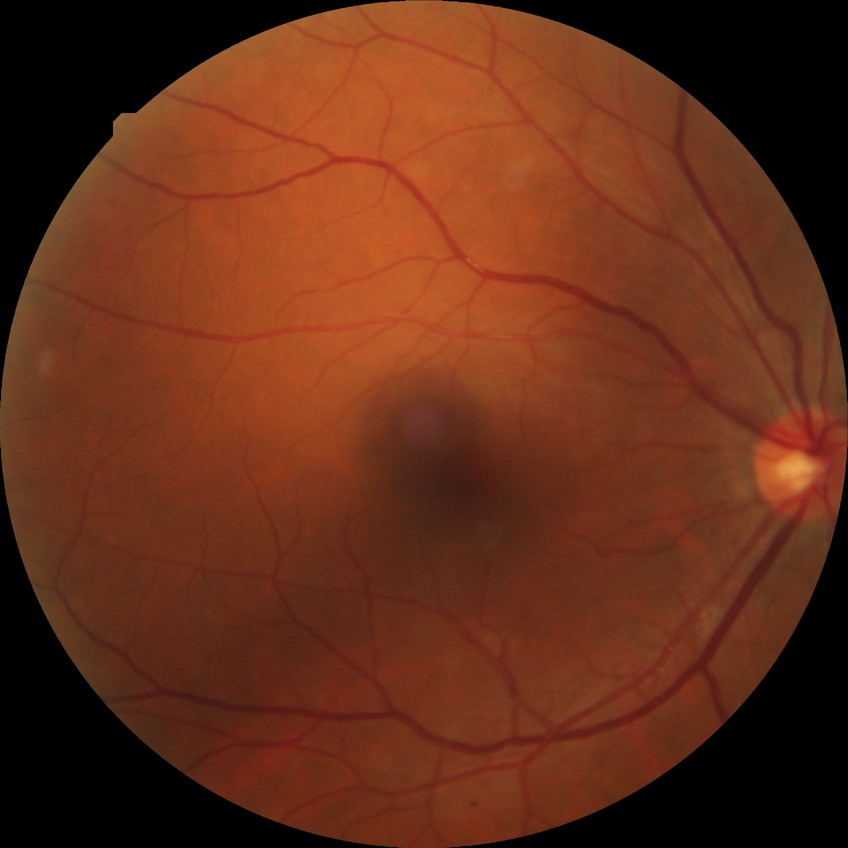 diabetic retinopathy (DR): pre-proliferative diabetic retinopathy (PPDR).